Color fundus image; 45° FOV: 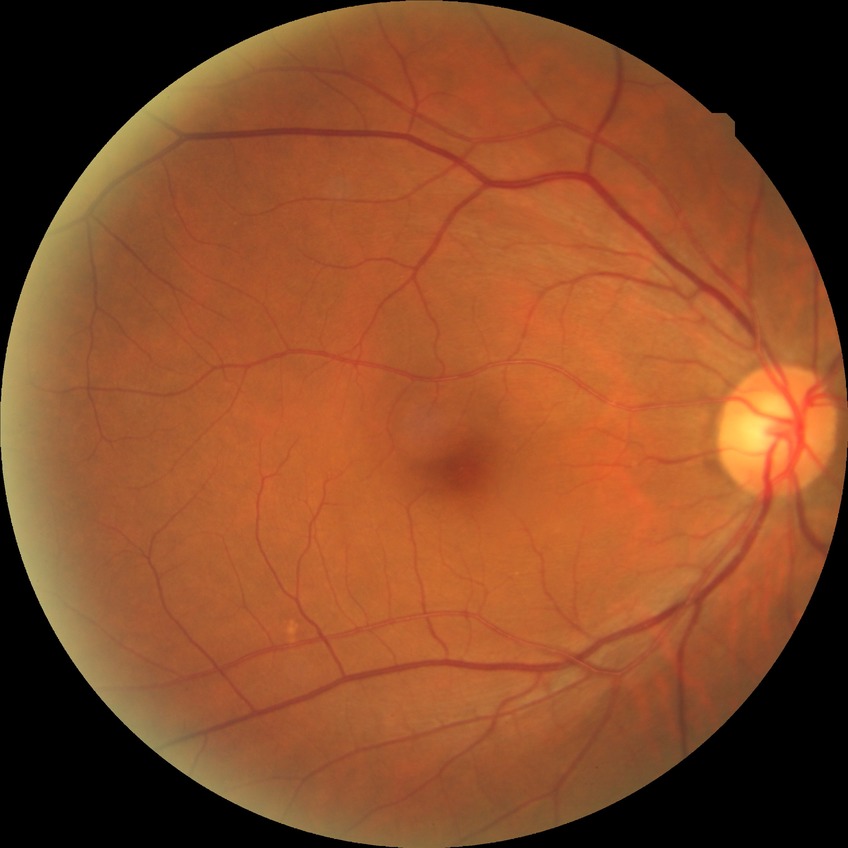

Modified Davis grade: NDR.
No apparent diabetic retinopathy.